848x848; color fundus image — 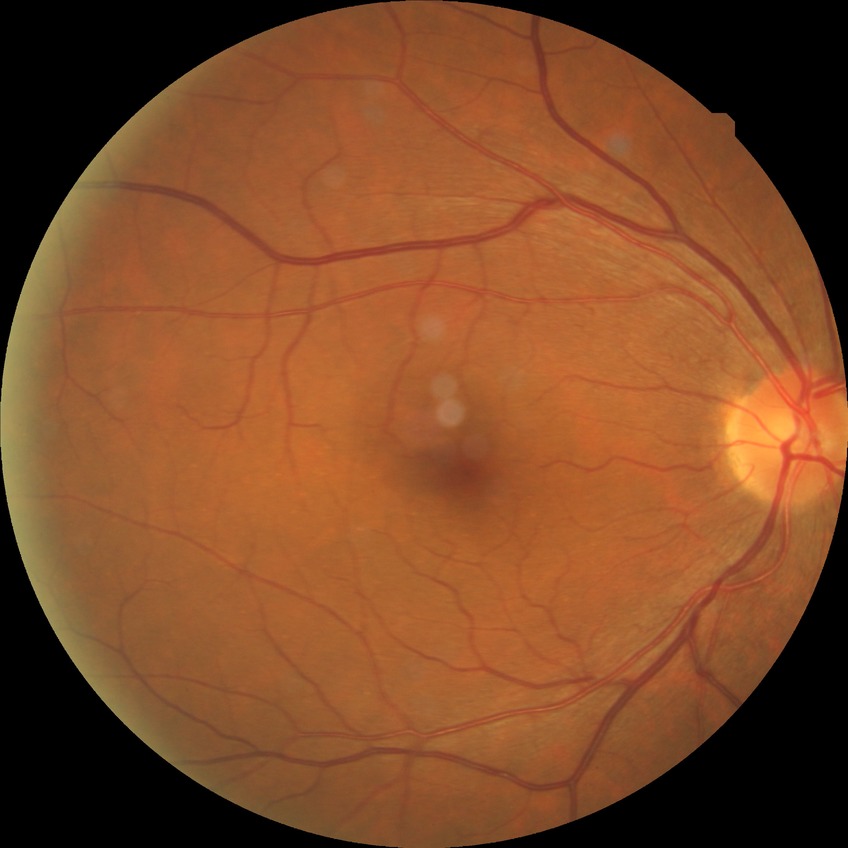
dr_impression: no signs of DR
davis_grade: NDR